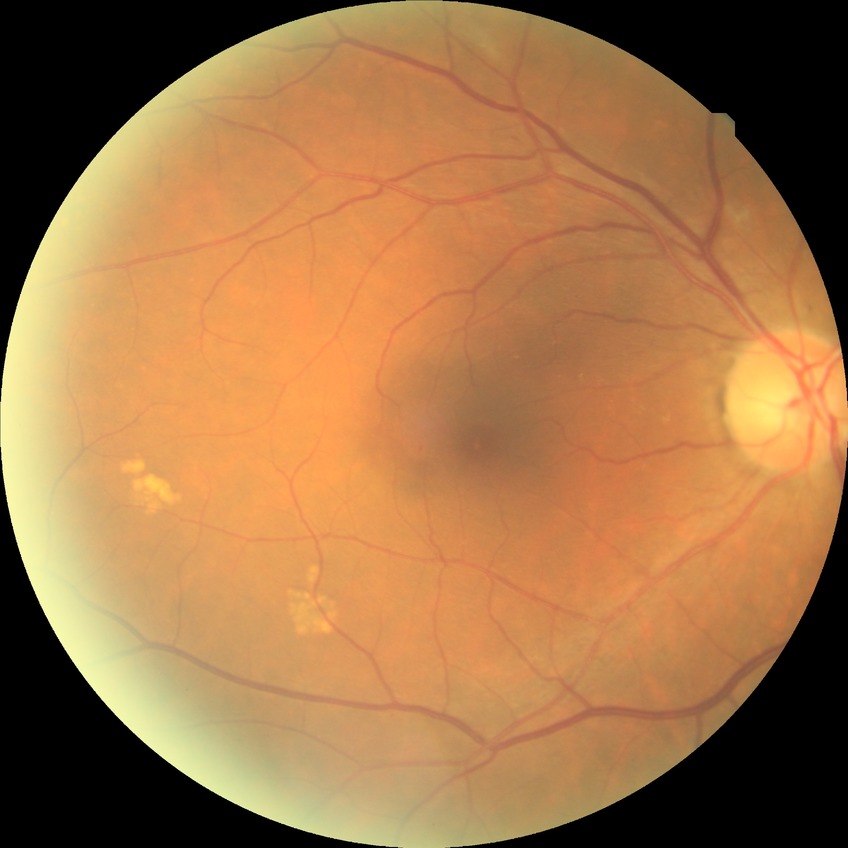 Assessment:
– diabetic retinopathy (DR): NDR (no diabetic retinopathy)